CFP: 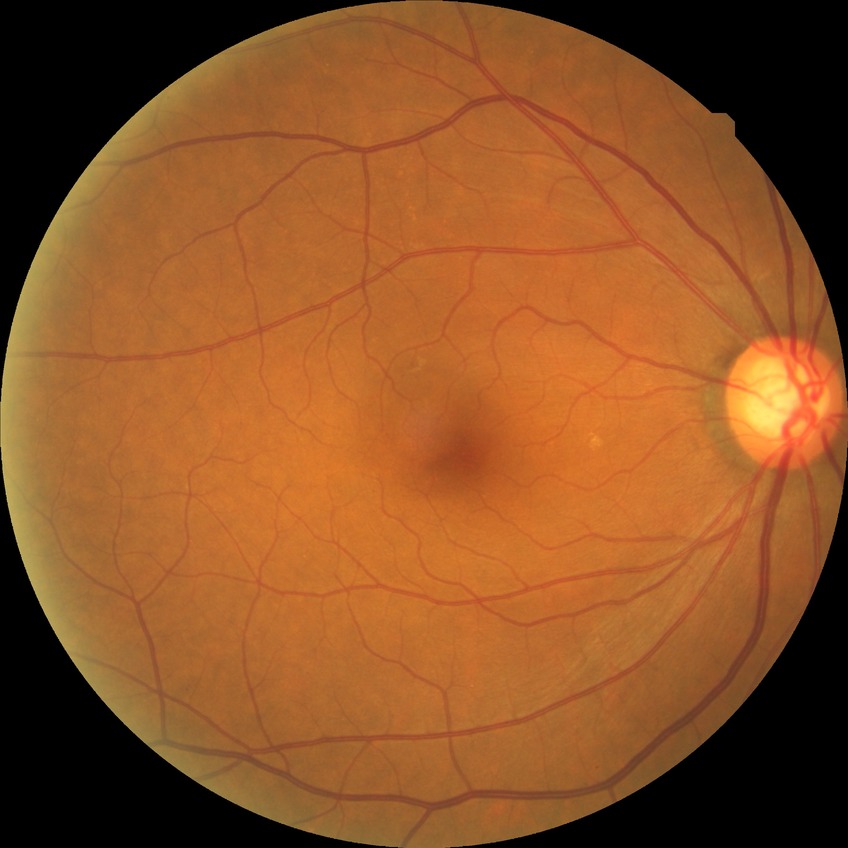 Diabetic retinopathy (DR) is NDR (no diabetic retinopathy).